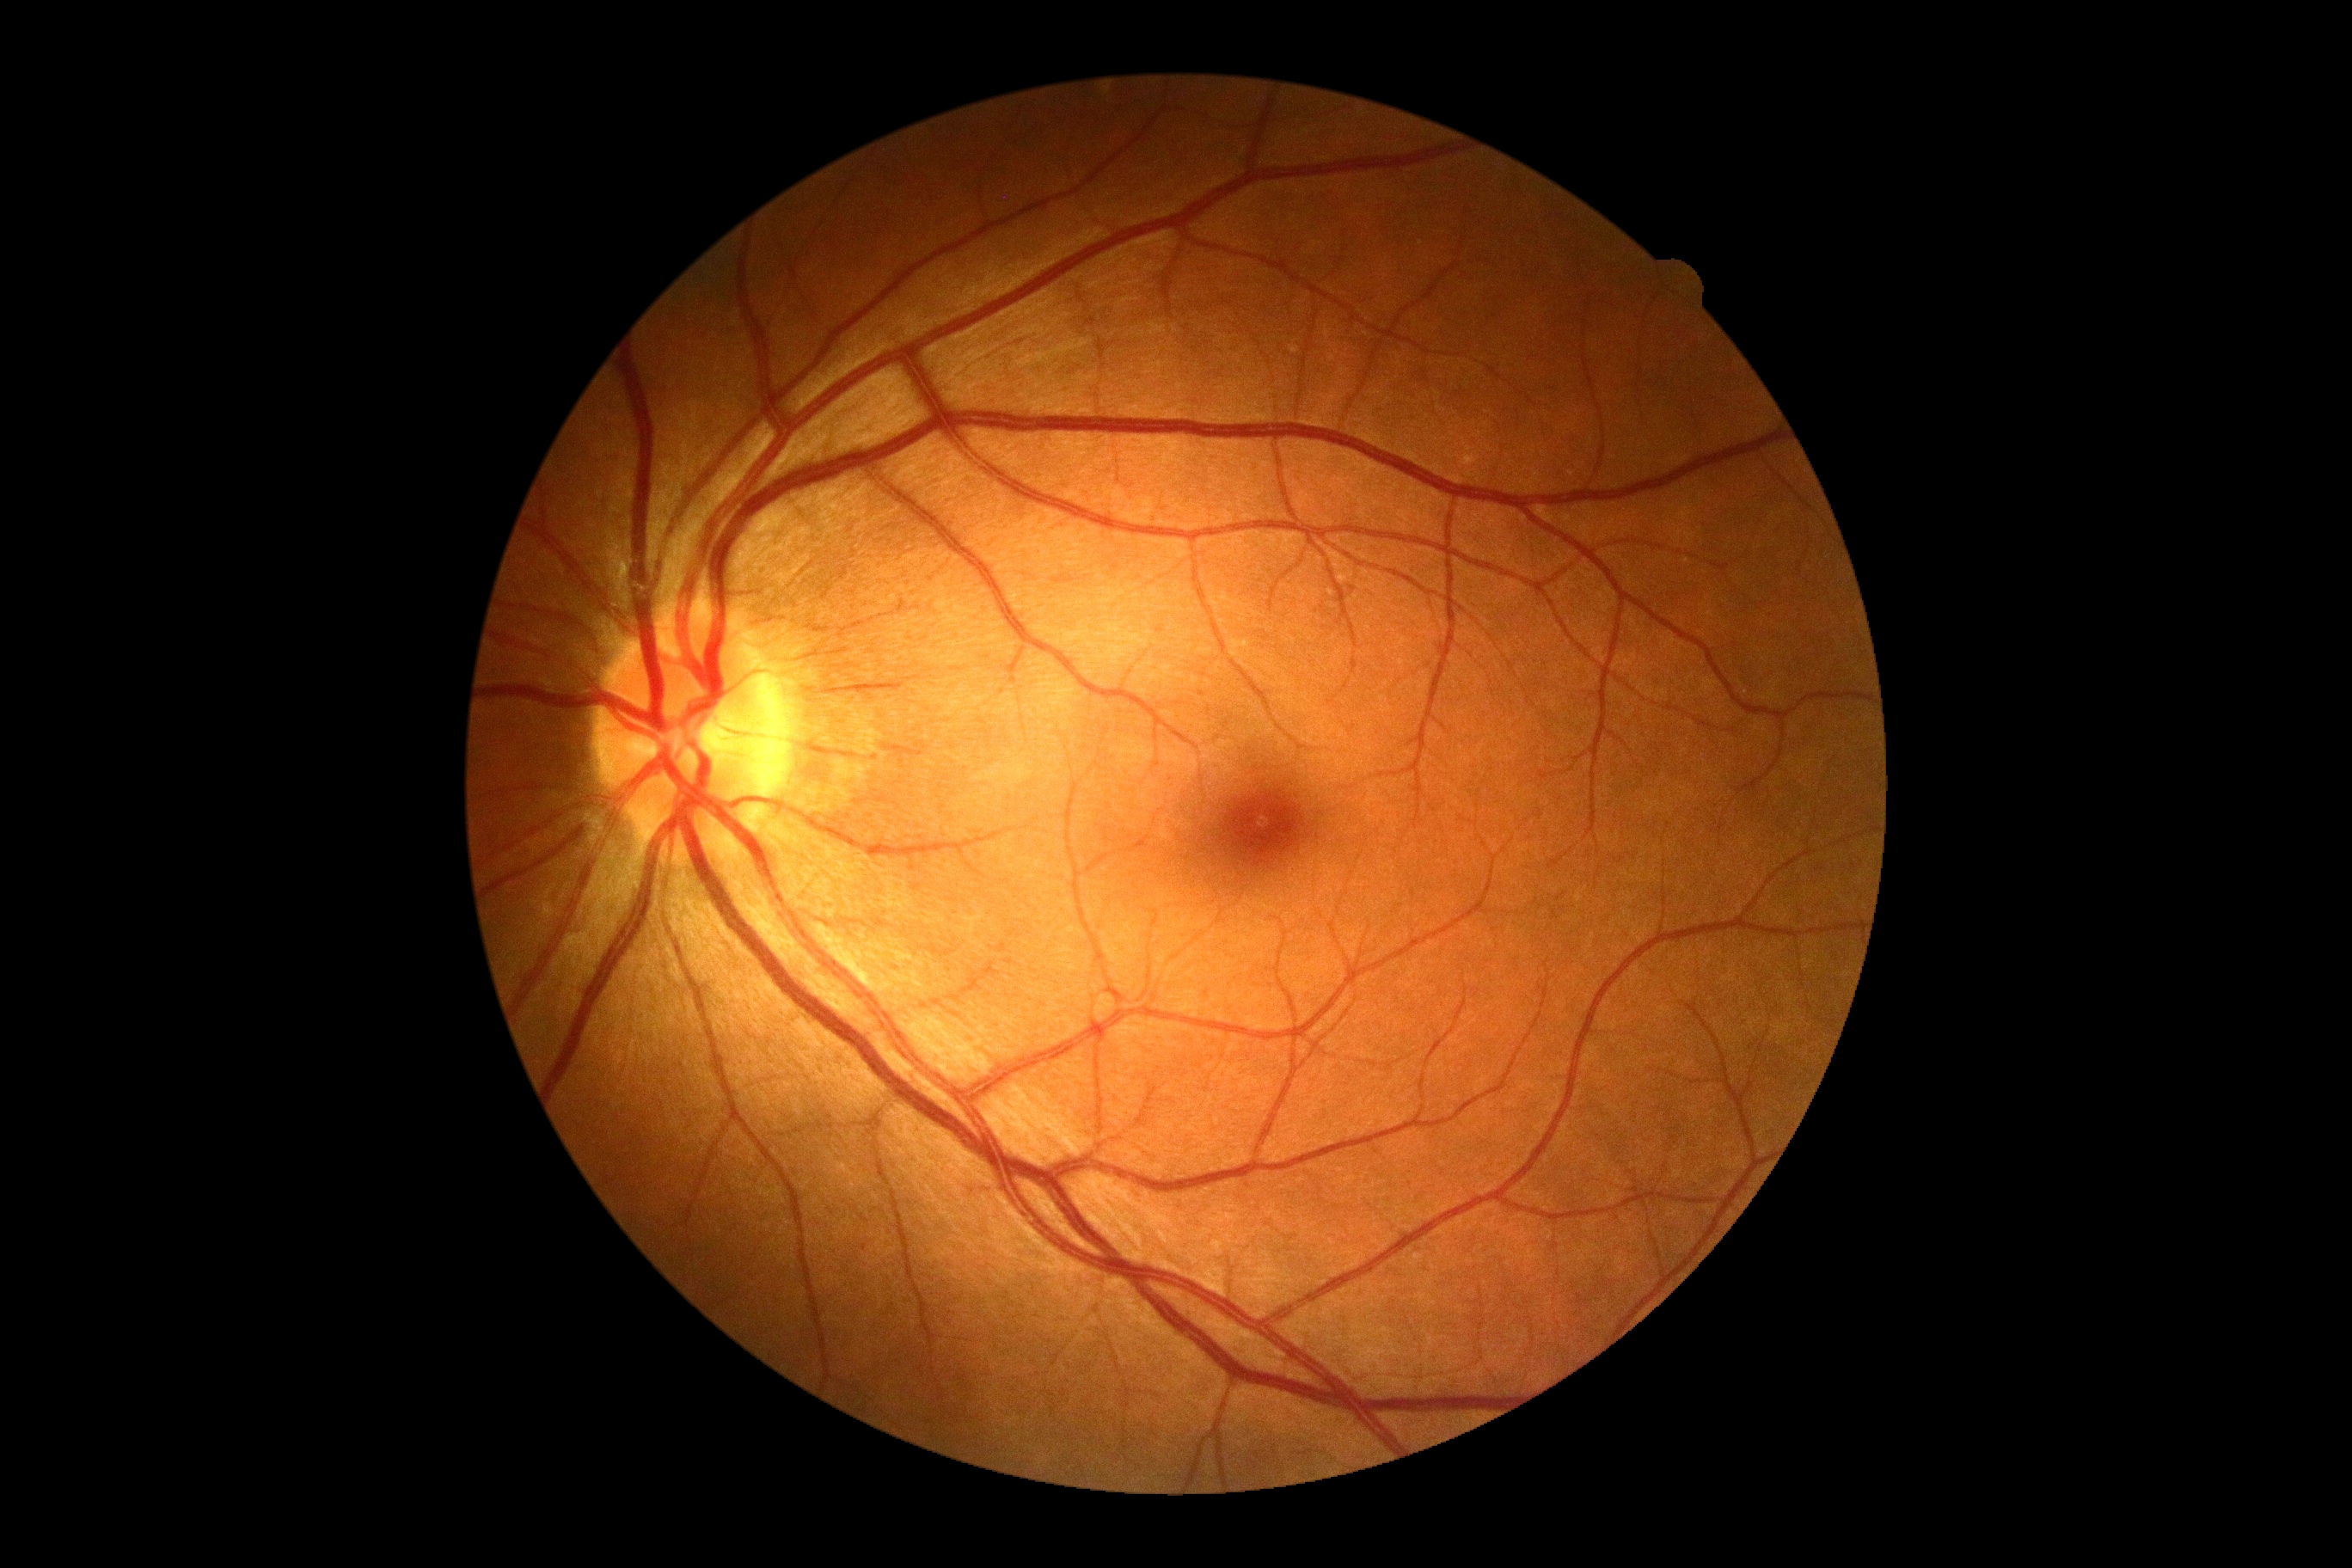

diabetic retinopathy@grade 0 (no apparent retinopathy).